Disc-centered field · fundus photo: 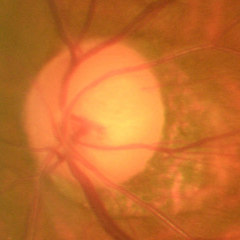 Impression = early-stage glaucoma.